Posterior pole photograph · acquired with a NIDEK AFC-230:
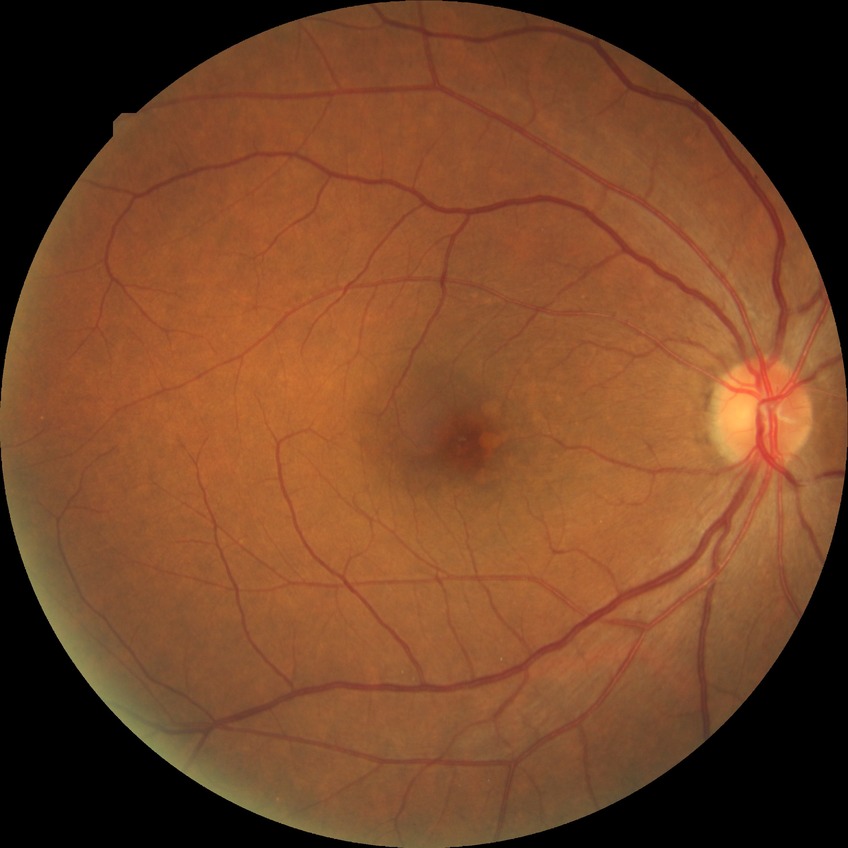 modified Davis classification: simple diabetic retinopathy.